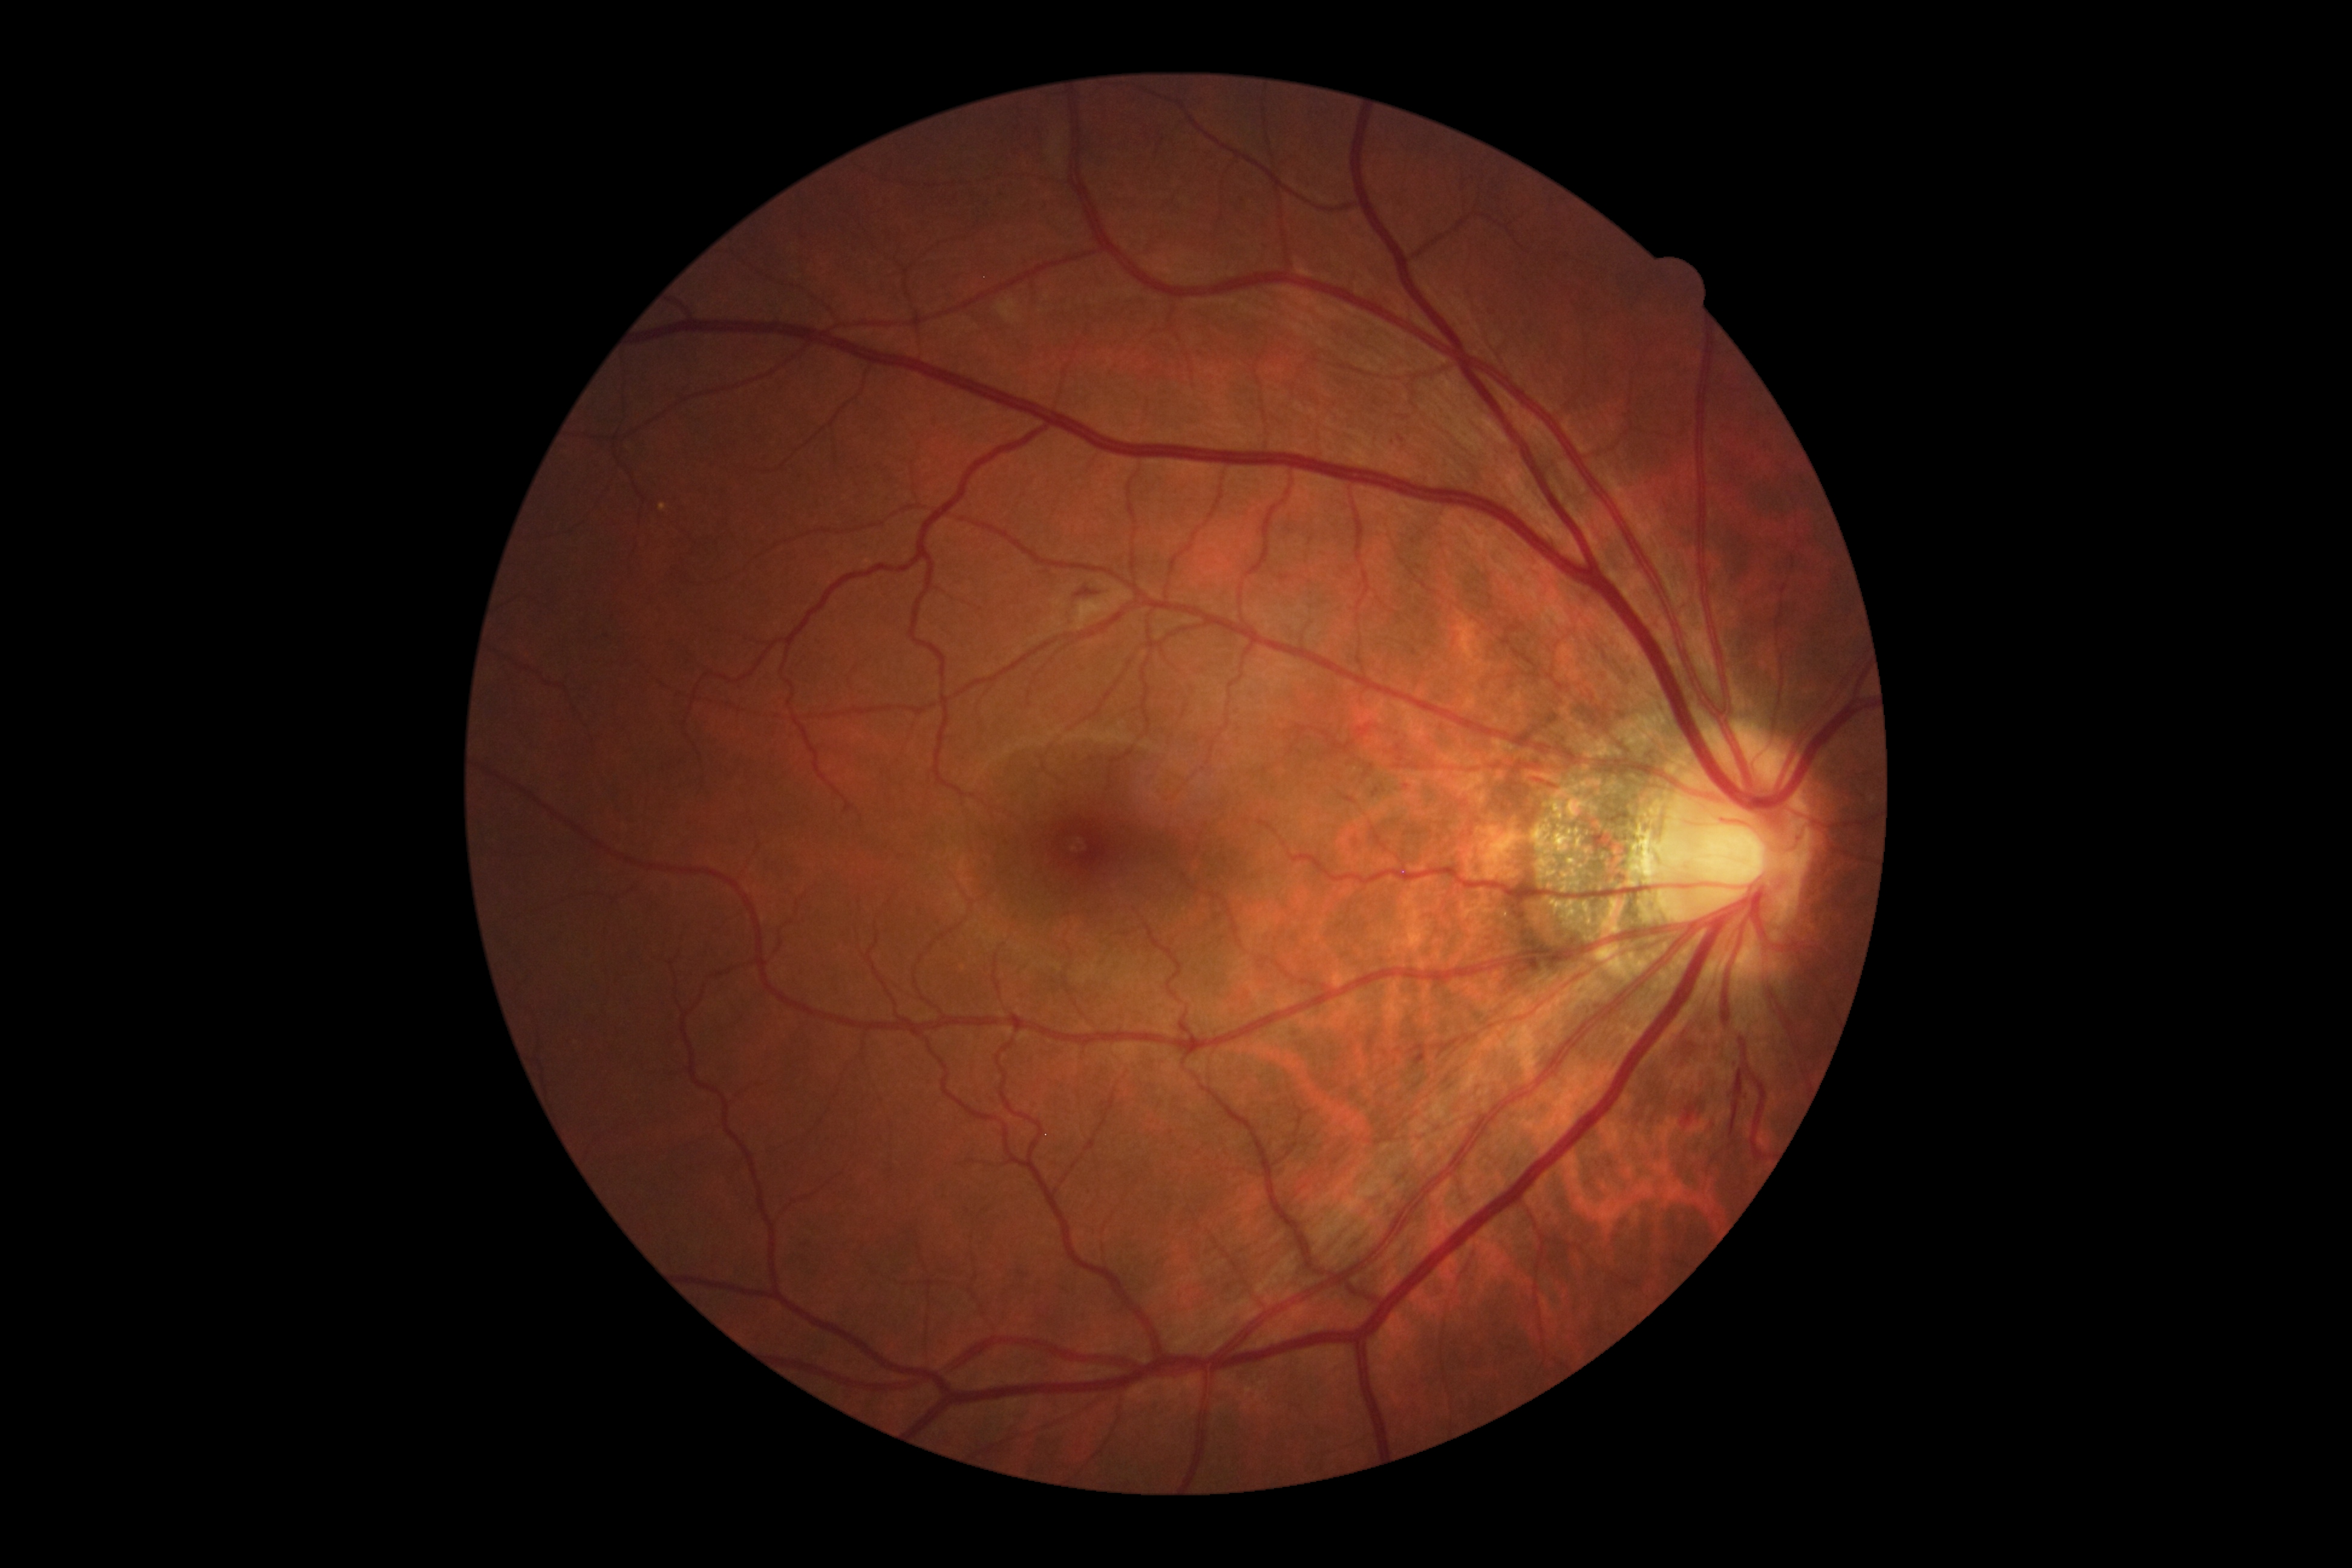
Diabetic retinopathy (DR): grade 2 (moderate NPDR).
The retinopathy is classified as non-proliferative diabetic retinopathy.